Color fundus image:
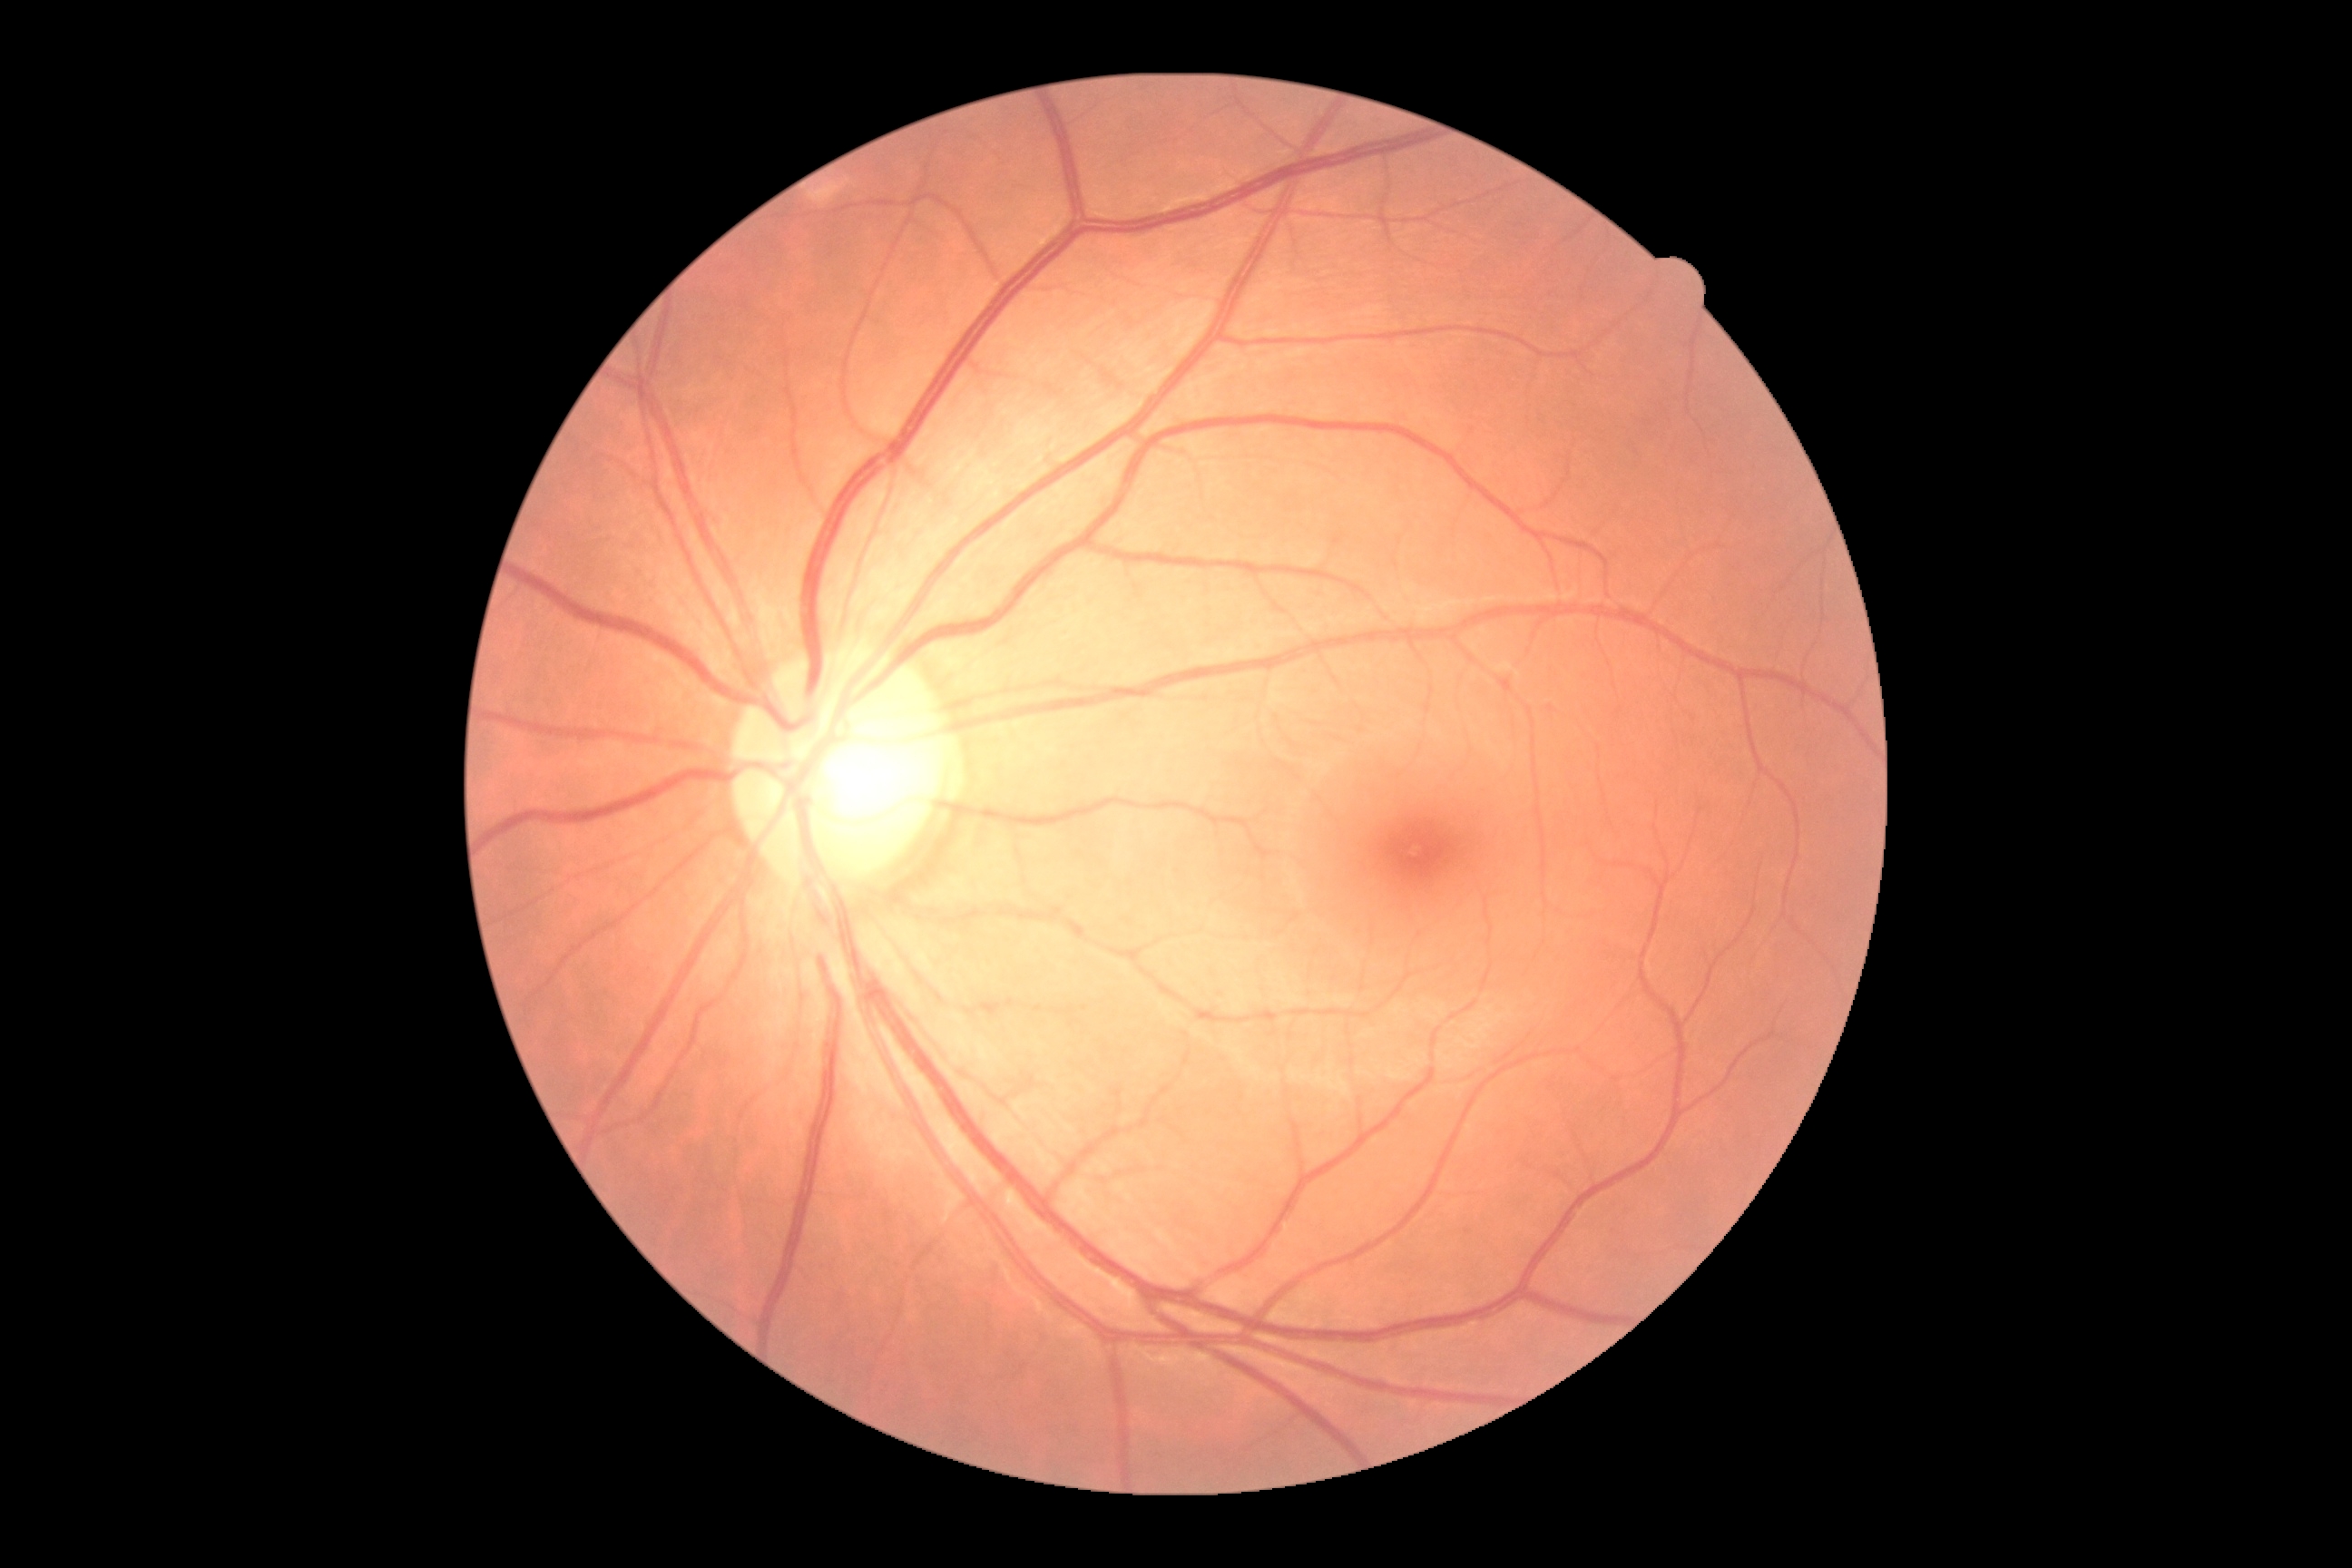

DR stage: no apparent diabetic retinopathy (grade 0) — no visible signs of diabetic retinopathy.